Image size 1240x1240; wide-field fundus image from infant ROP screening
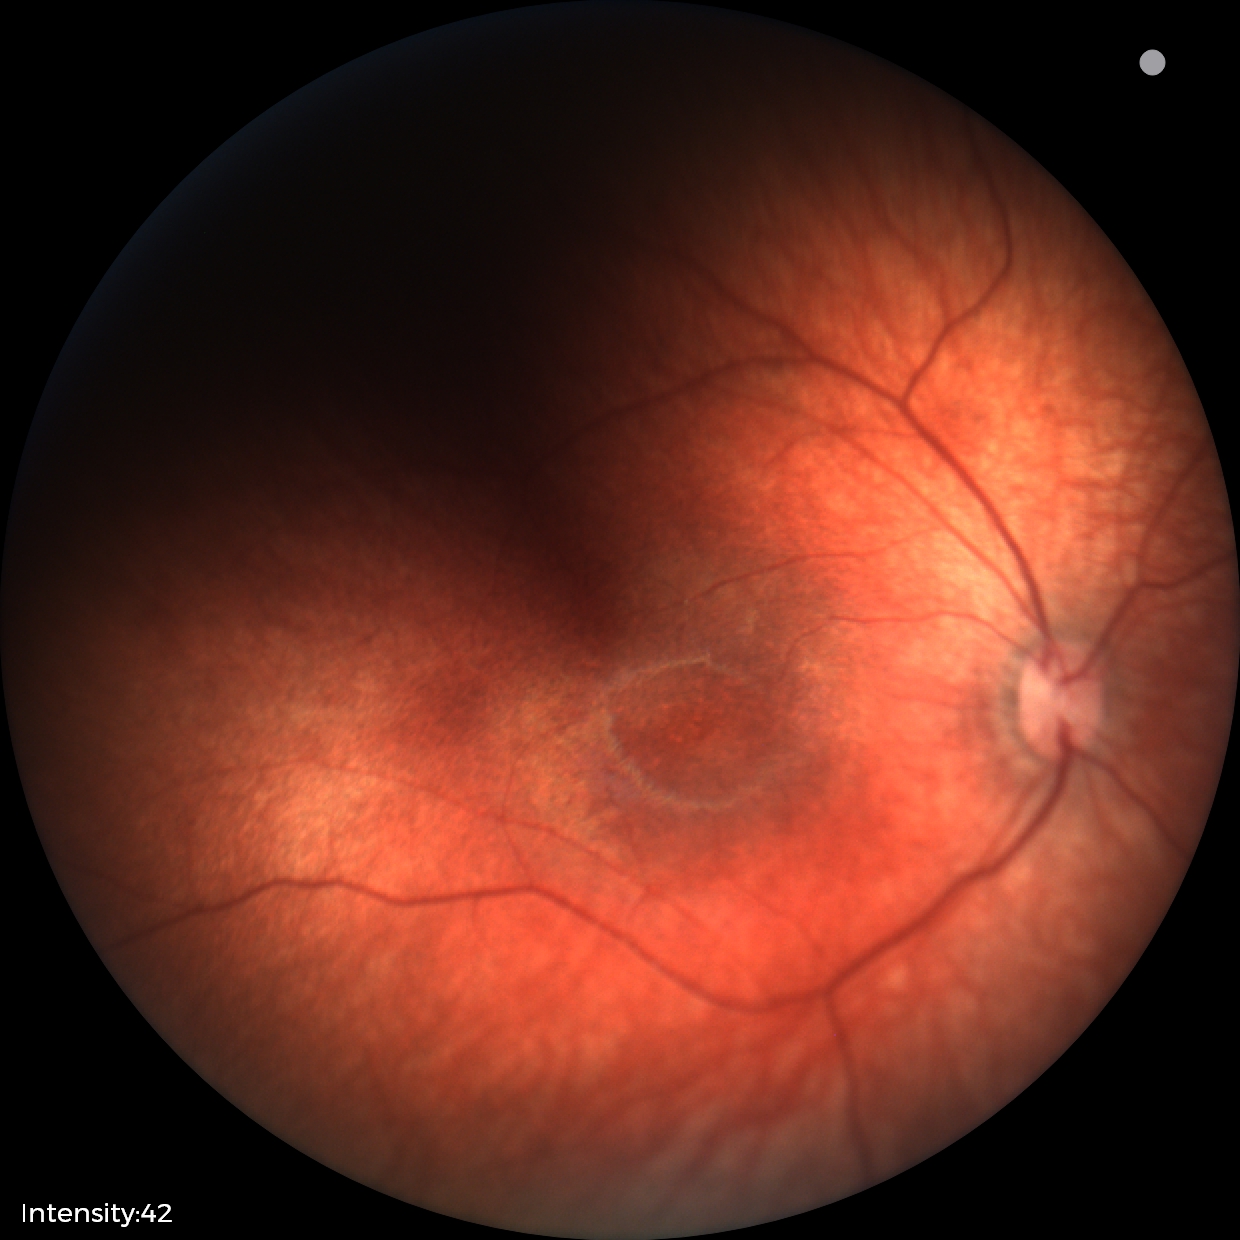 Normal screening examination.